FOV: 45 degrees
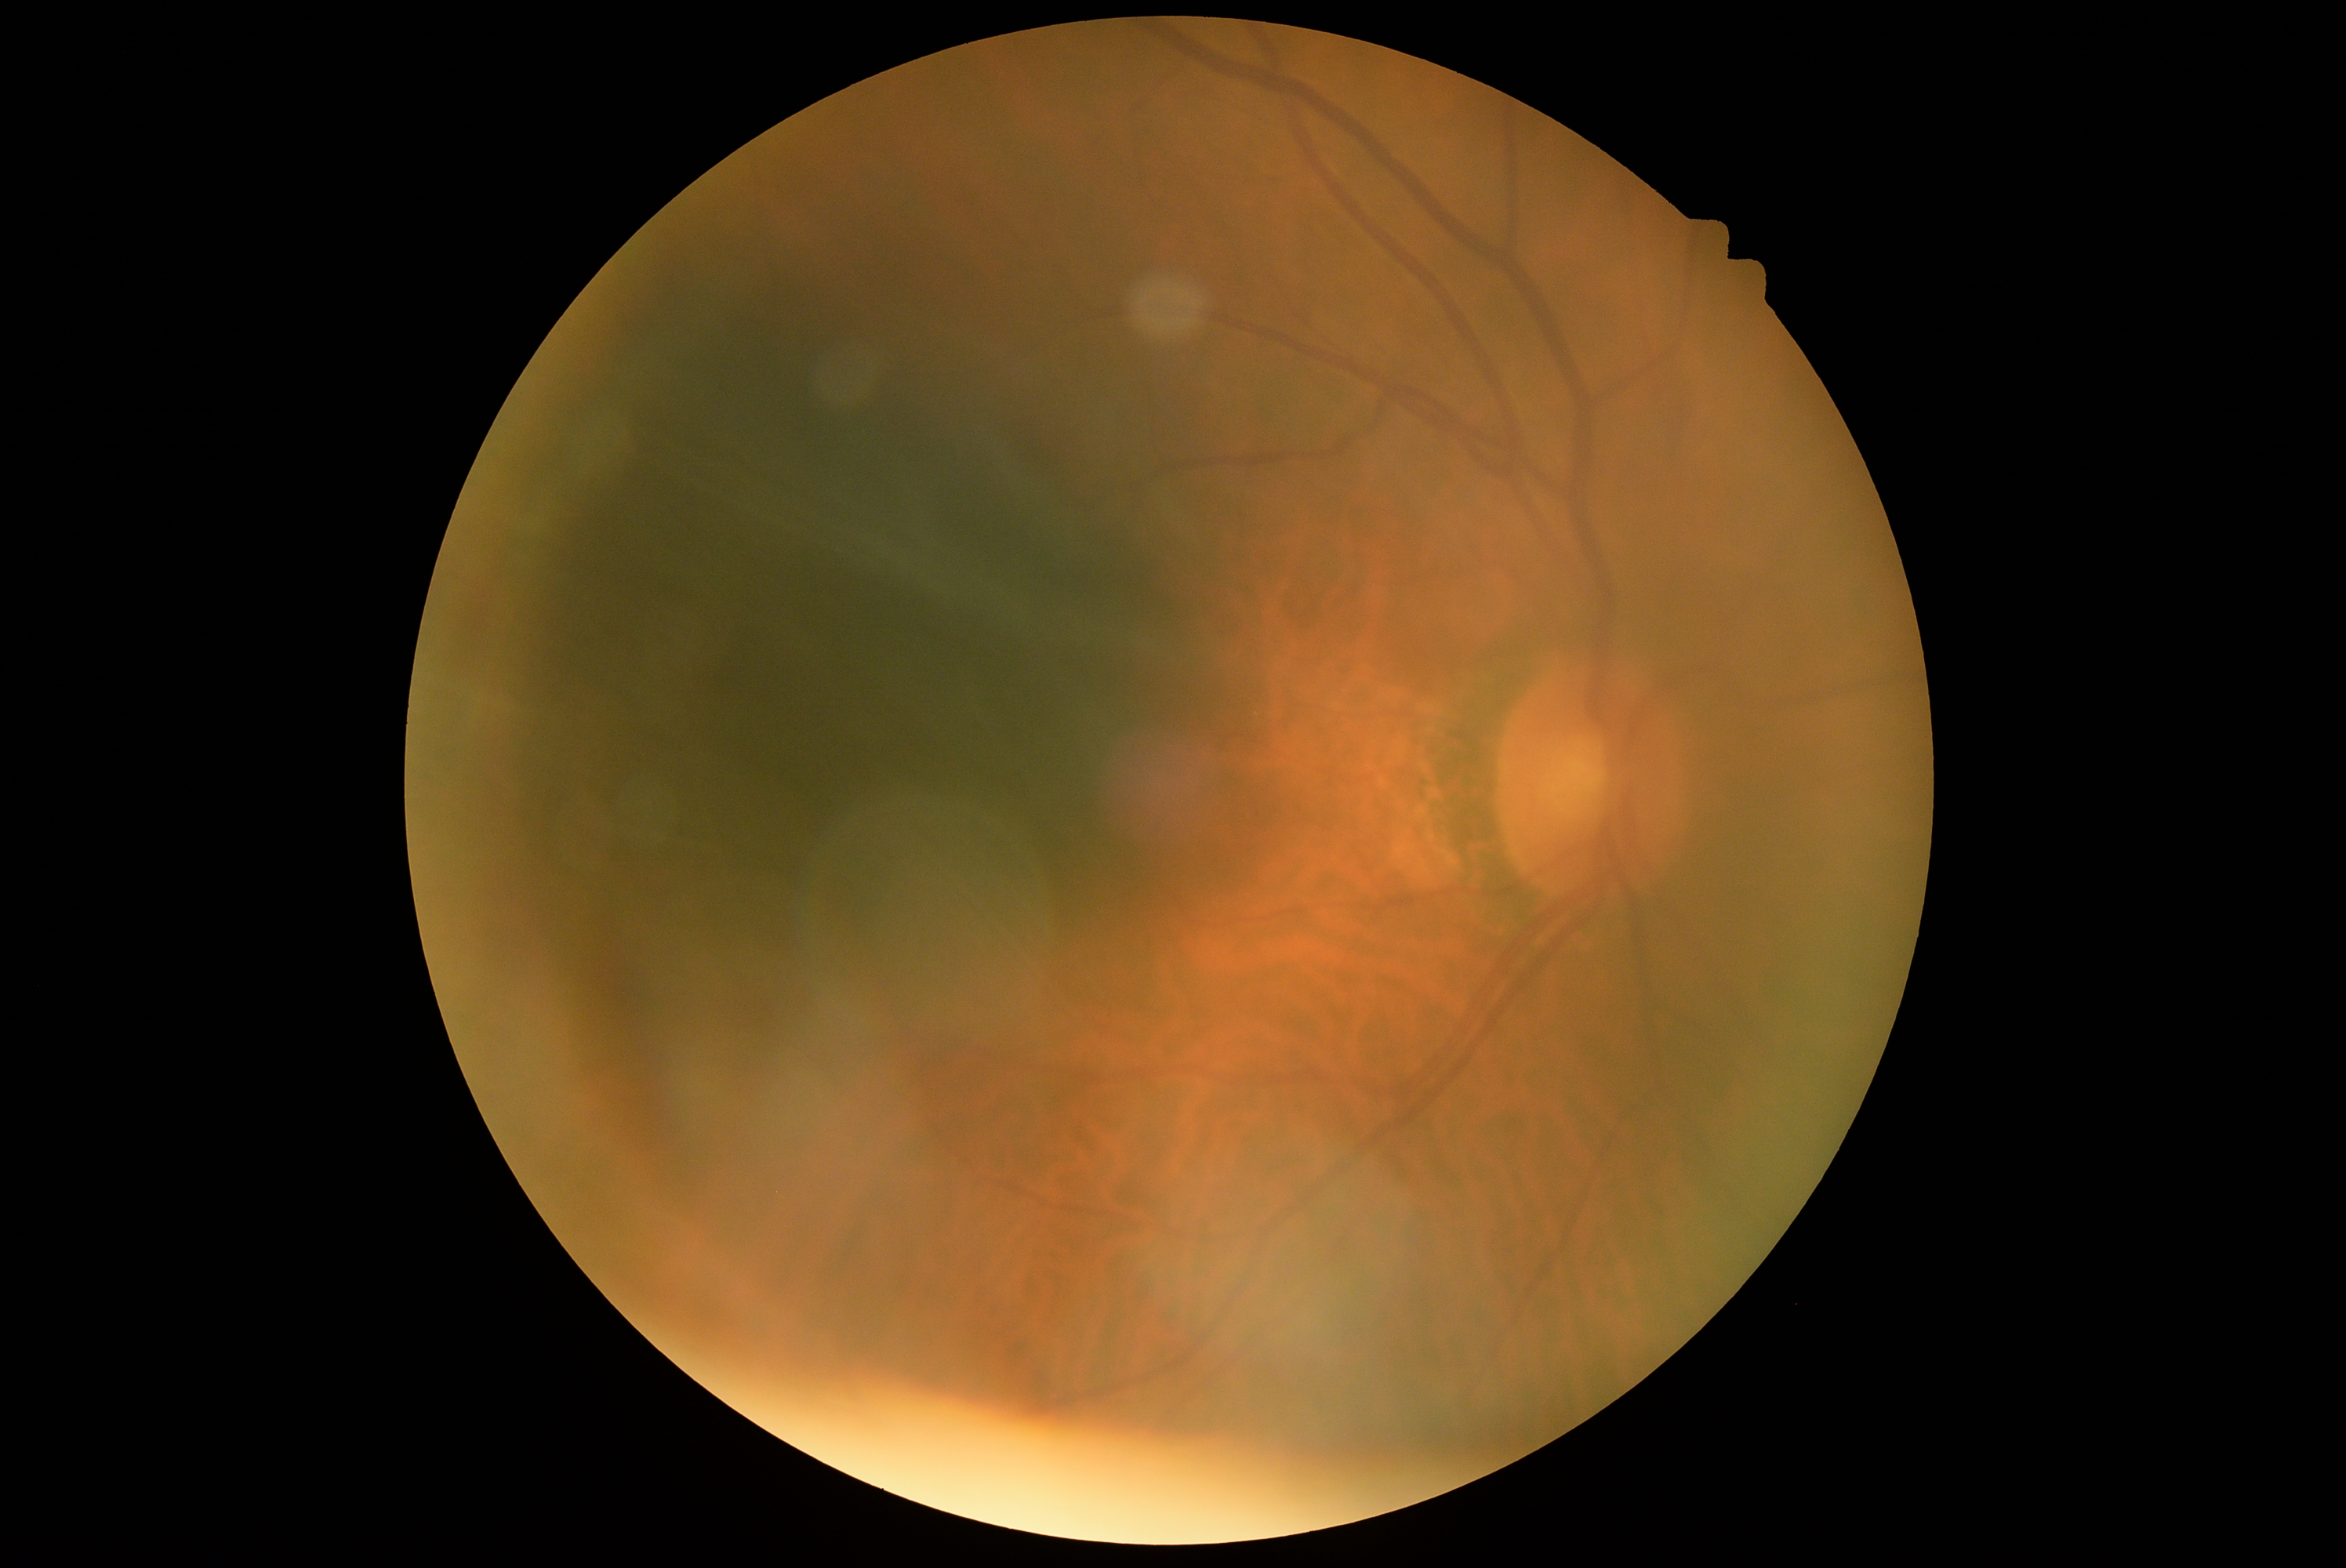
– DR severity — 0